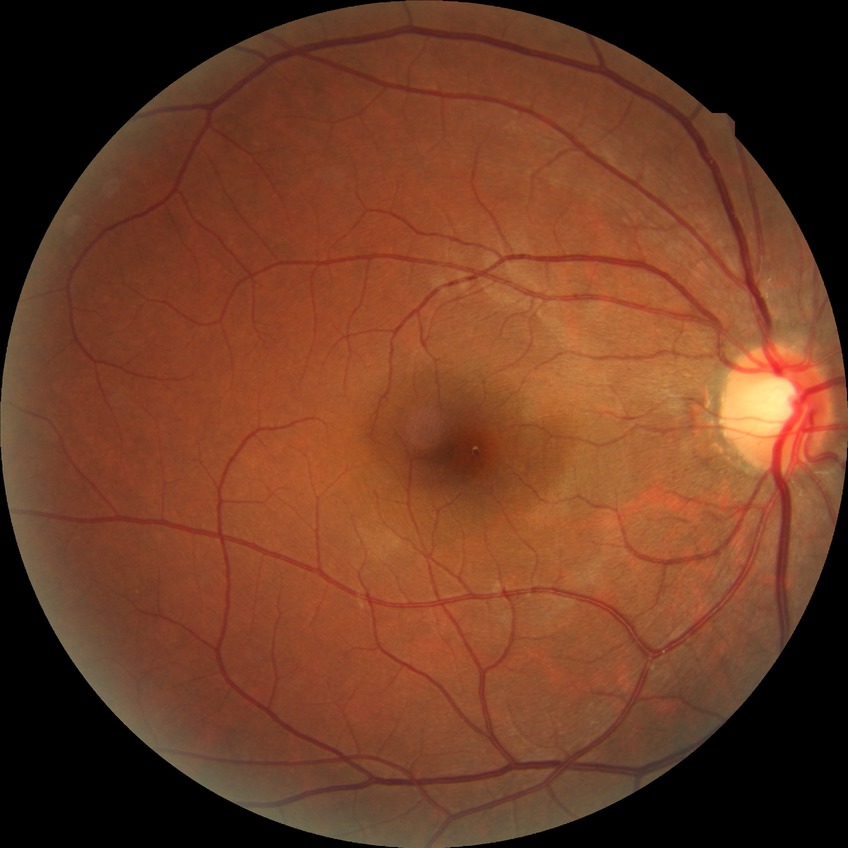 Diabetic retinopathy (DR): no diabetic retinopathy (NDR).